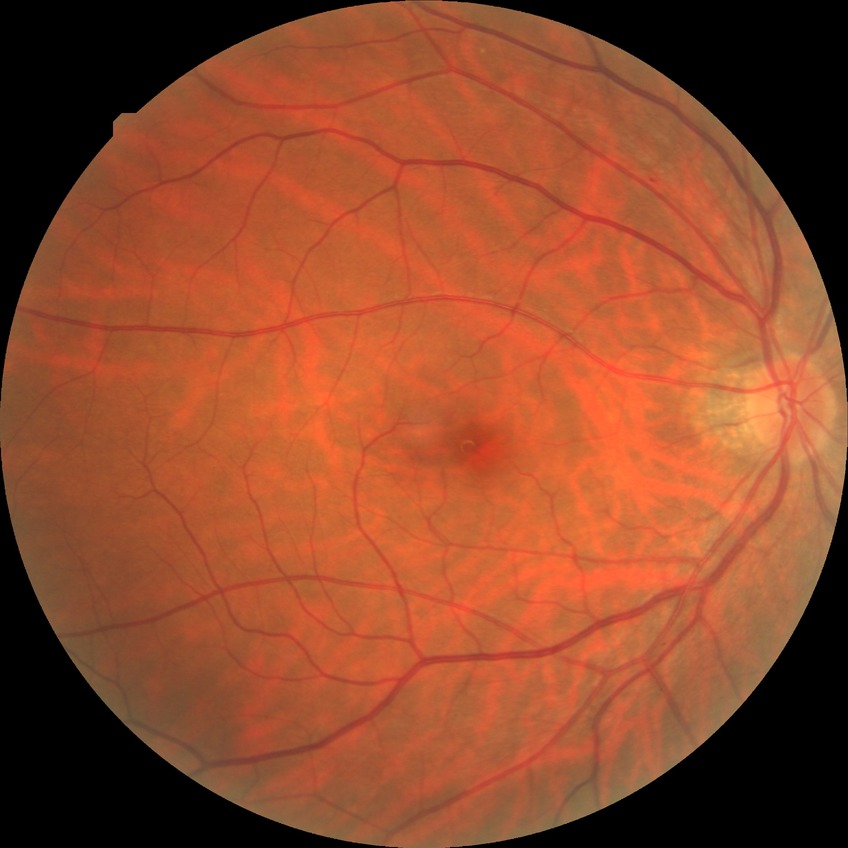 Diabetic retinopathy (DR): NDR (no diabetic retinopathy).